Retinal fundus photograph: 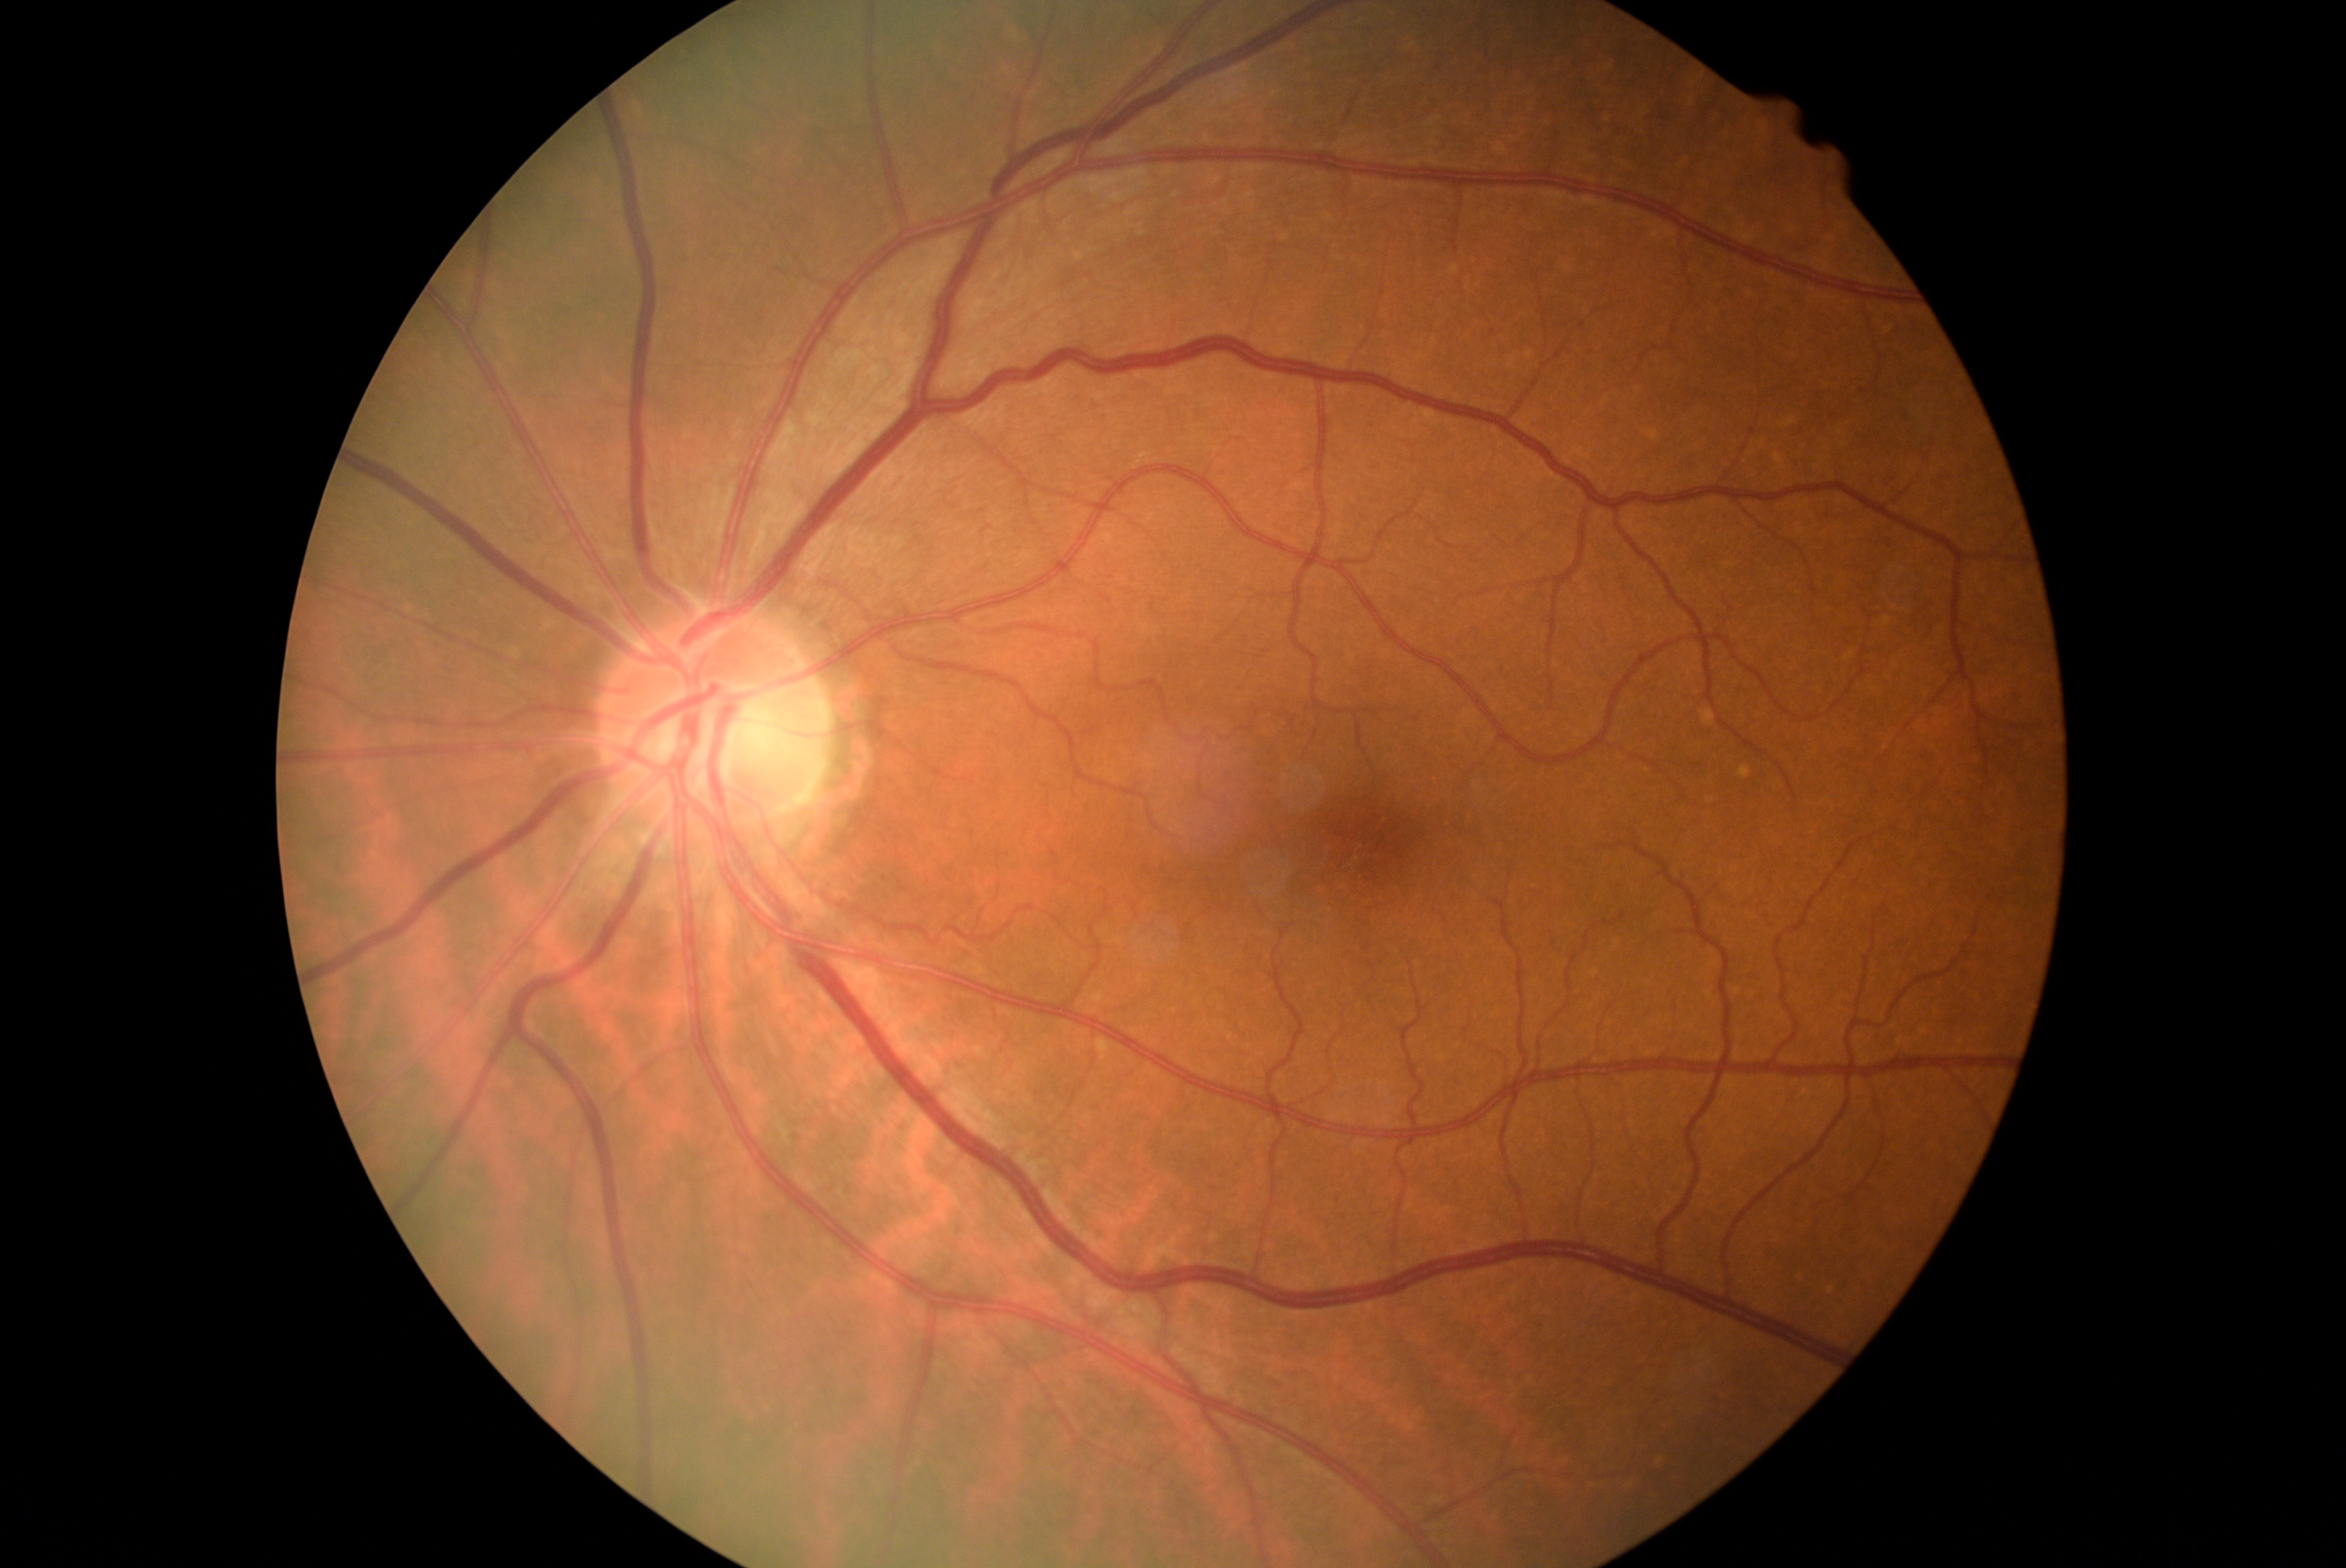
Annotations:
– DR impression: no DR findings
– diabetic retinopathy severity: grade 0 — no visible signs of diabetic retinopathy